Modified Davis classification · 848 x 848 pixels · nonmydriatic · camera: NIDEK AFC-230 · retinal fundus photograph:
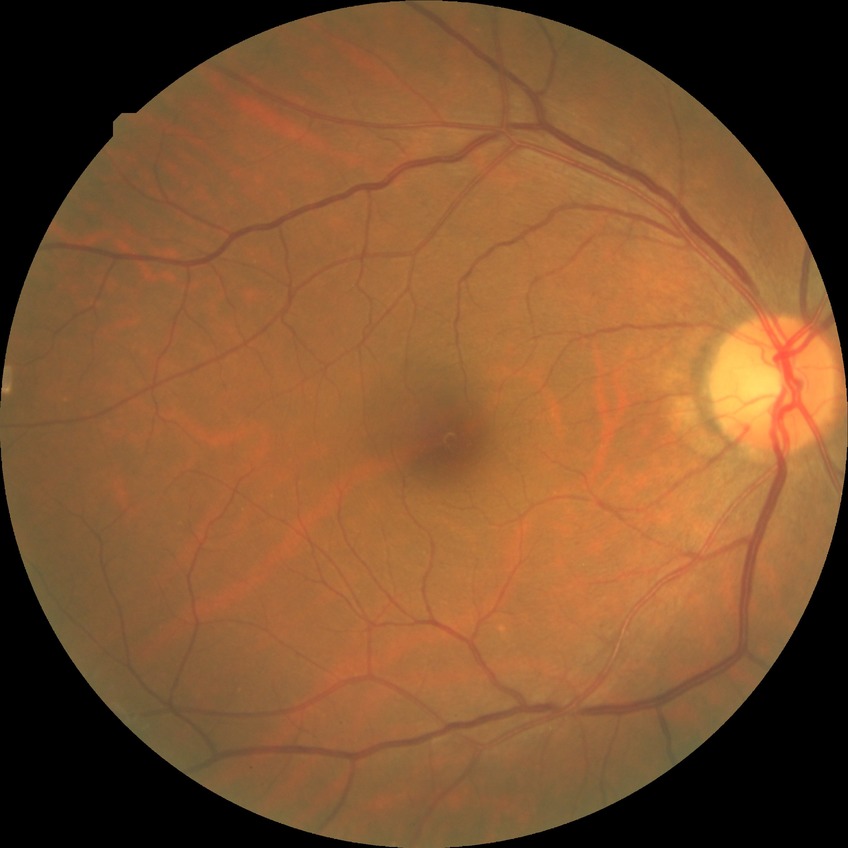

Diabetic retinopathy (DR) is NDR (no diabetic retinopathy).